Nonmydriatic, camera: NIDEK AFC-230, 45 degree fundus photograph: 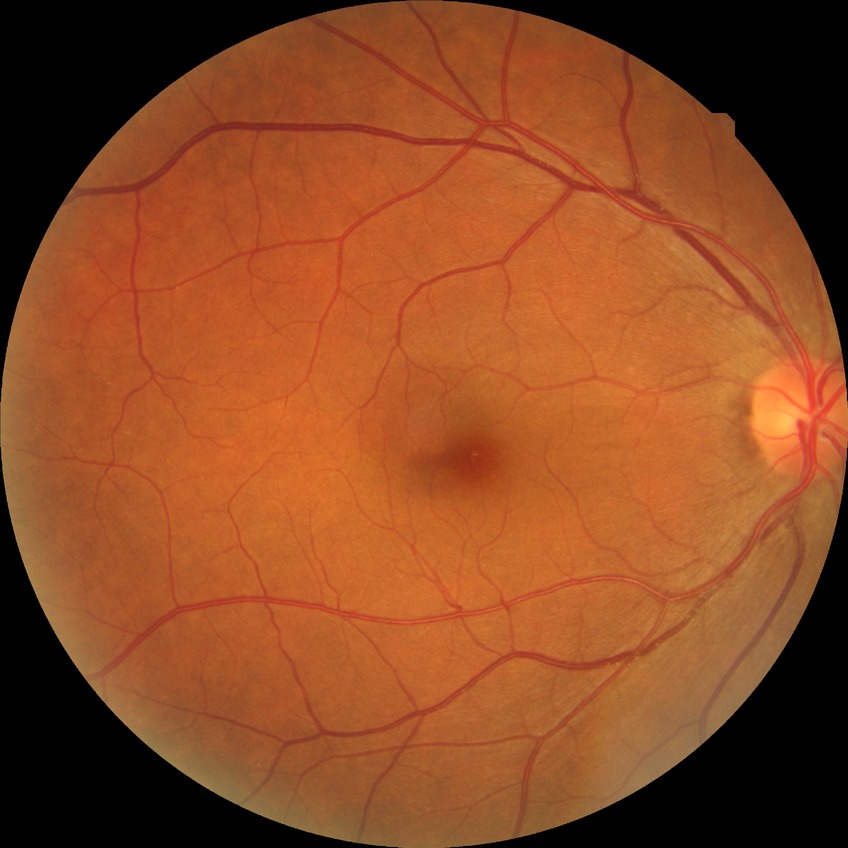 Modified Davis grading: no diabetic retinopathy.